Wide-field fundus photograph of an infant. Image size 640x480:
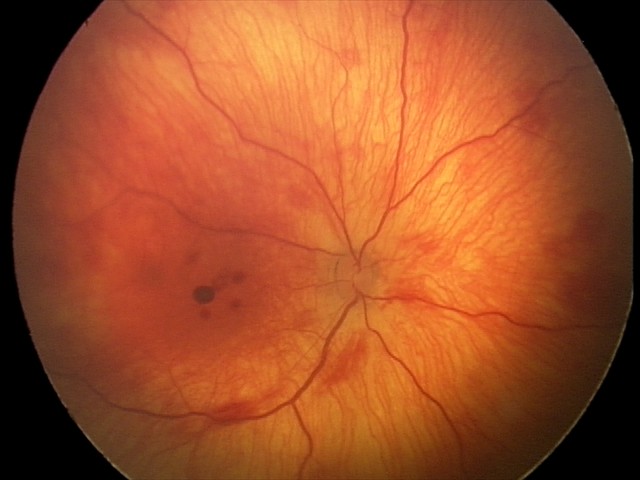

Finding: retinal hemorrhages.